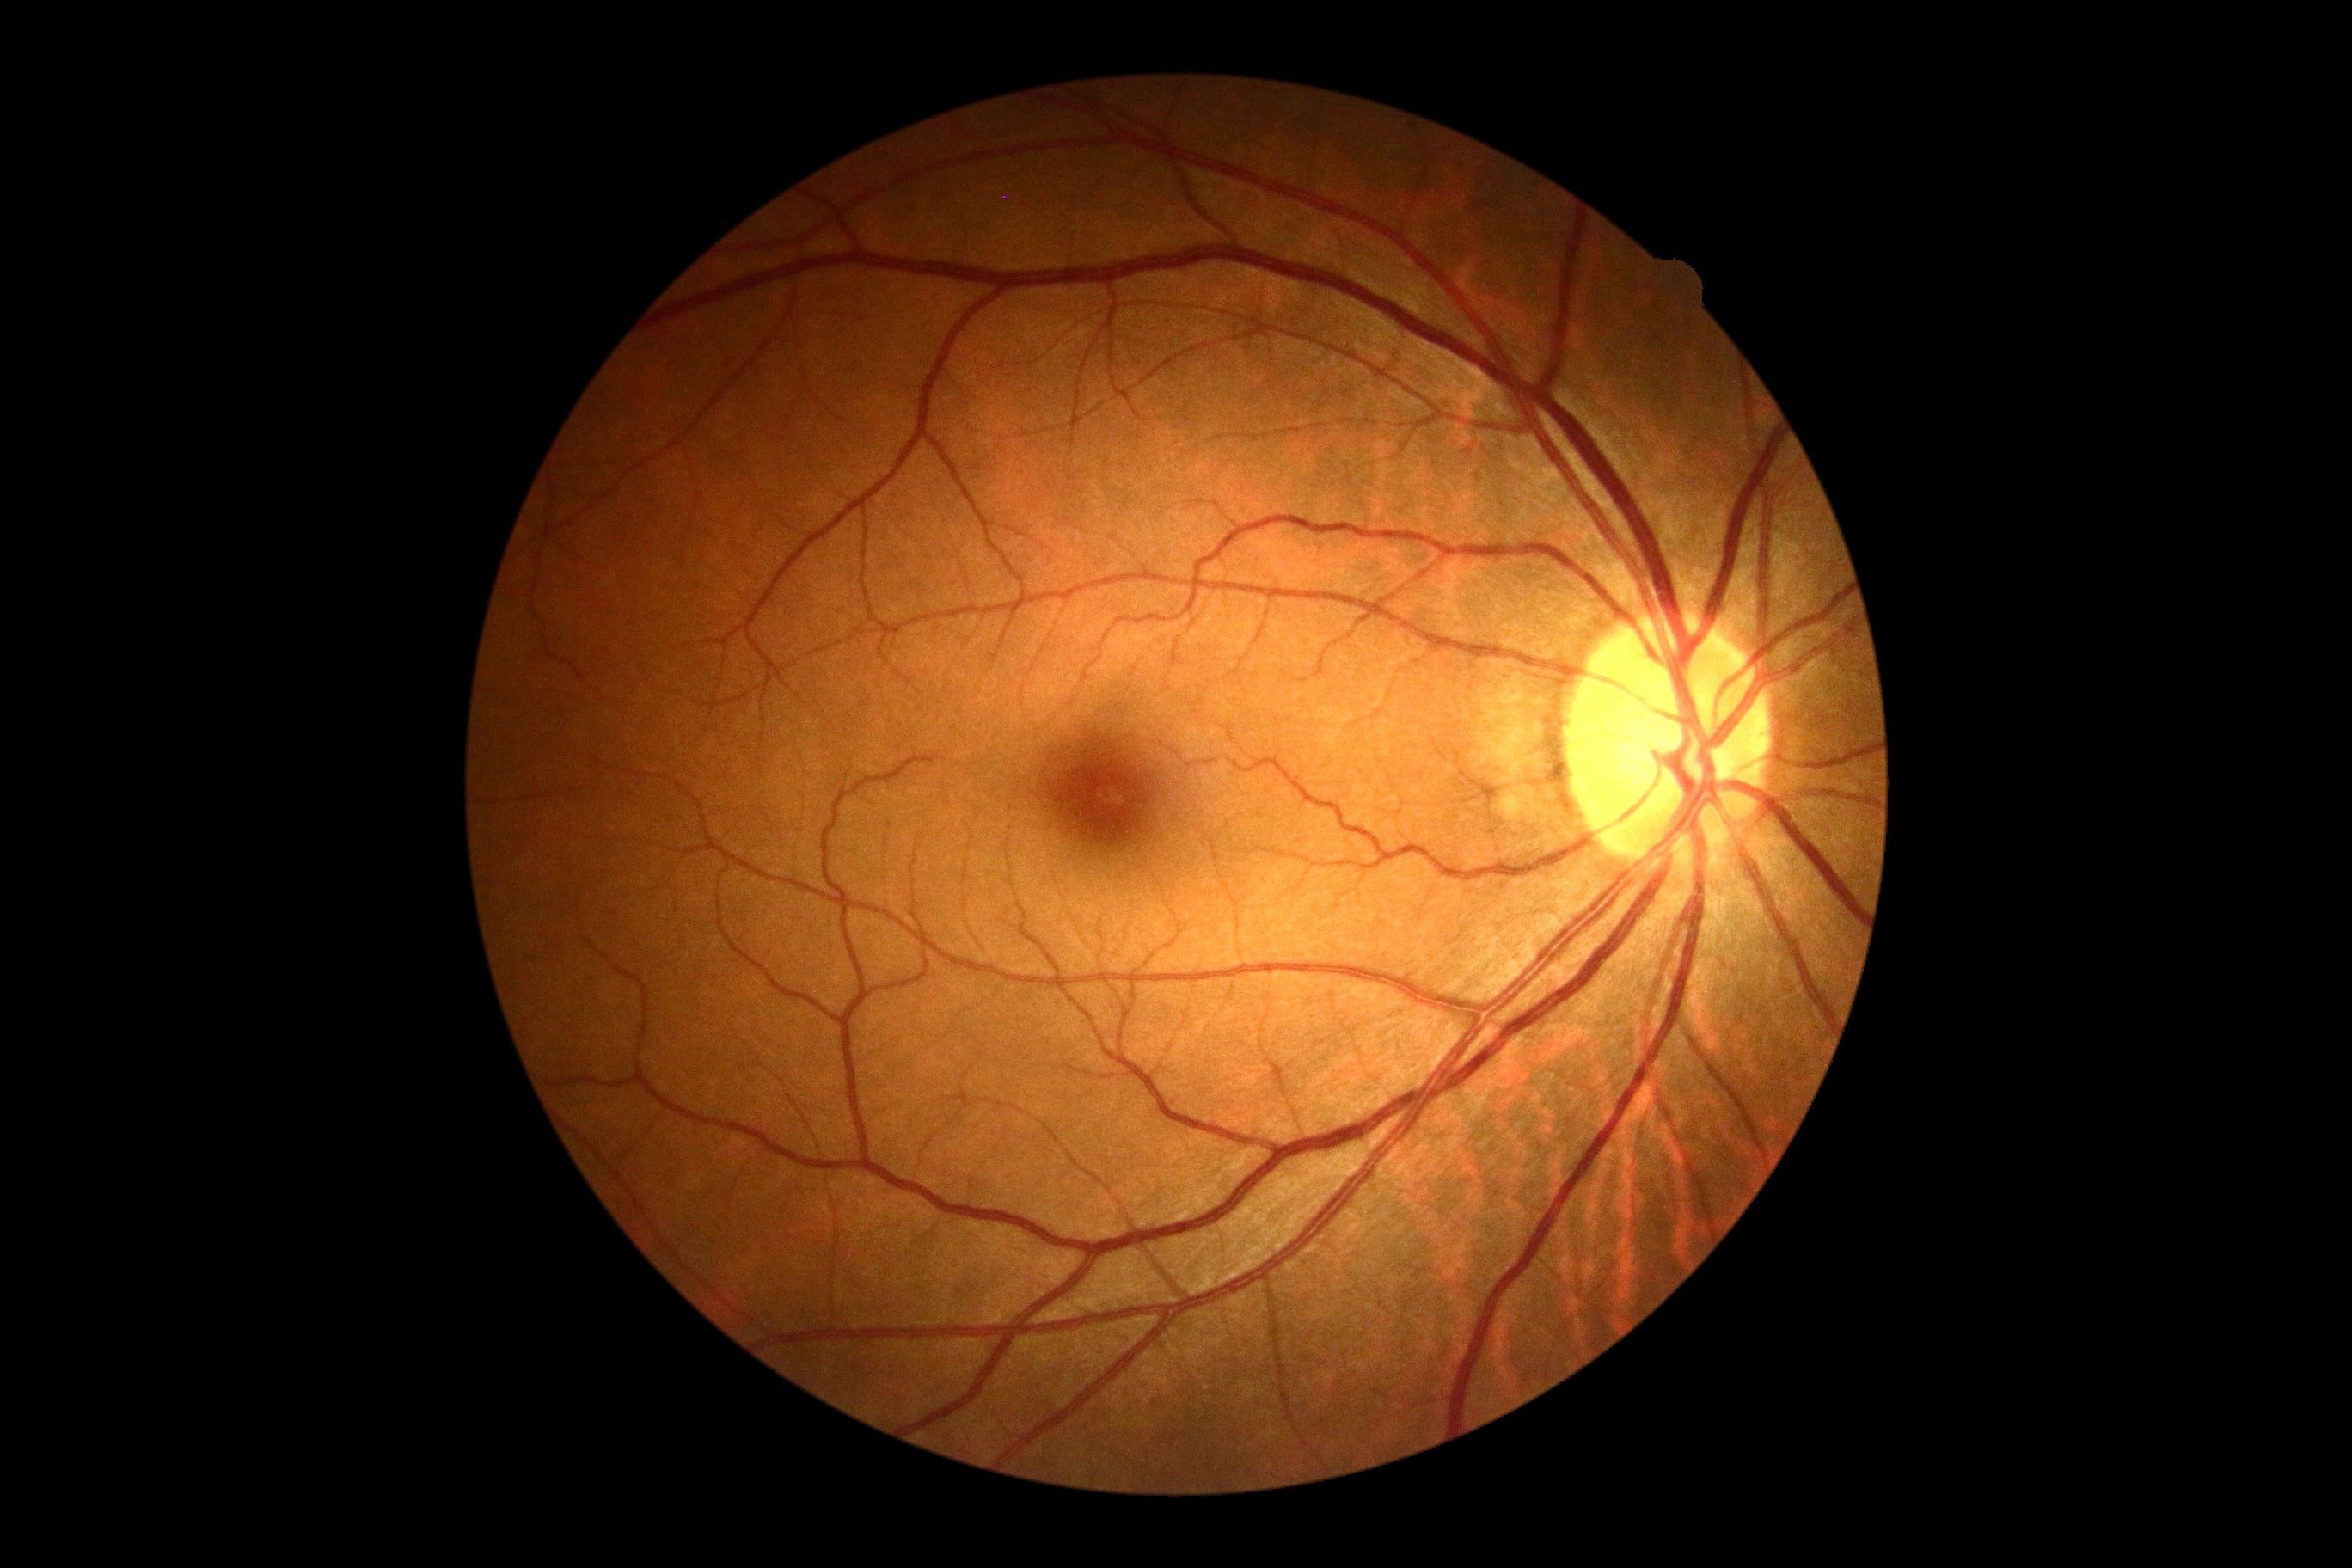

Diabetic retinopathy (DR) is 0.